Color fundus image · FOV: 45 degrees
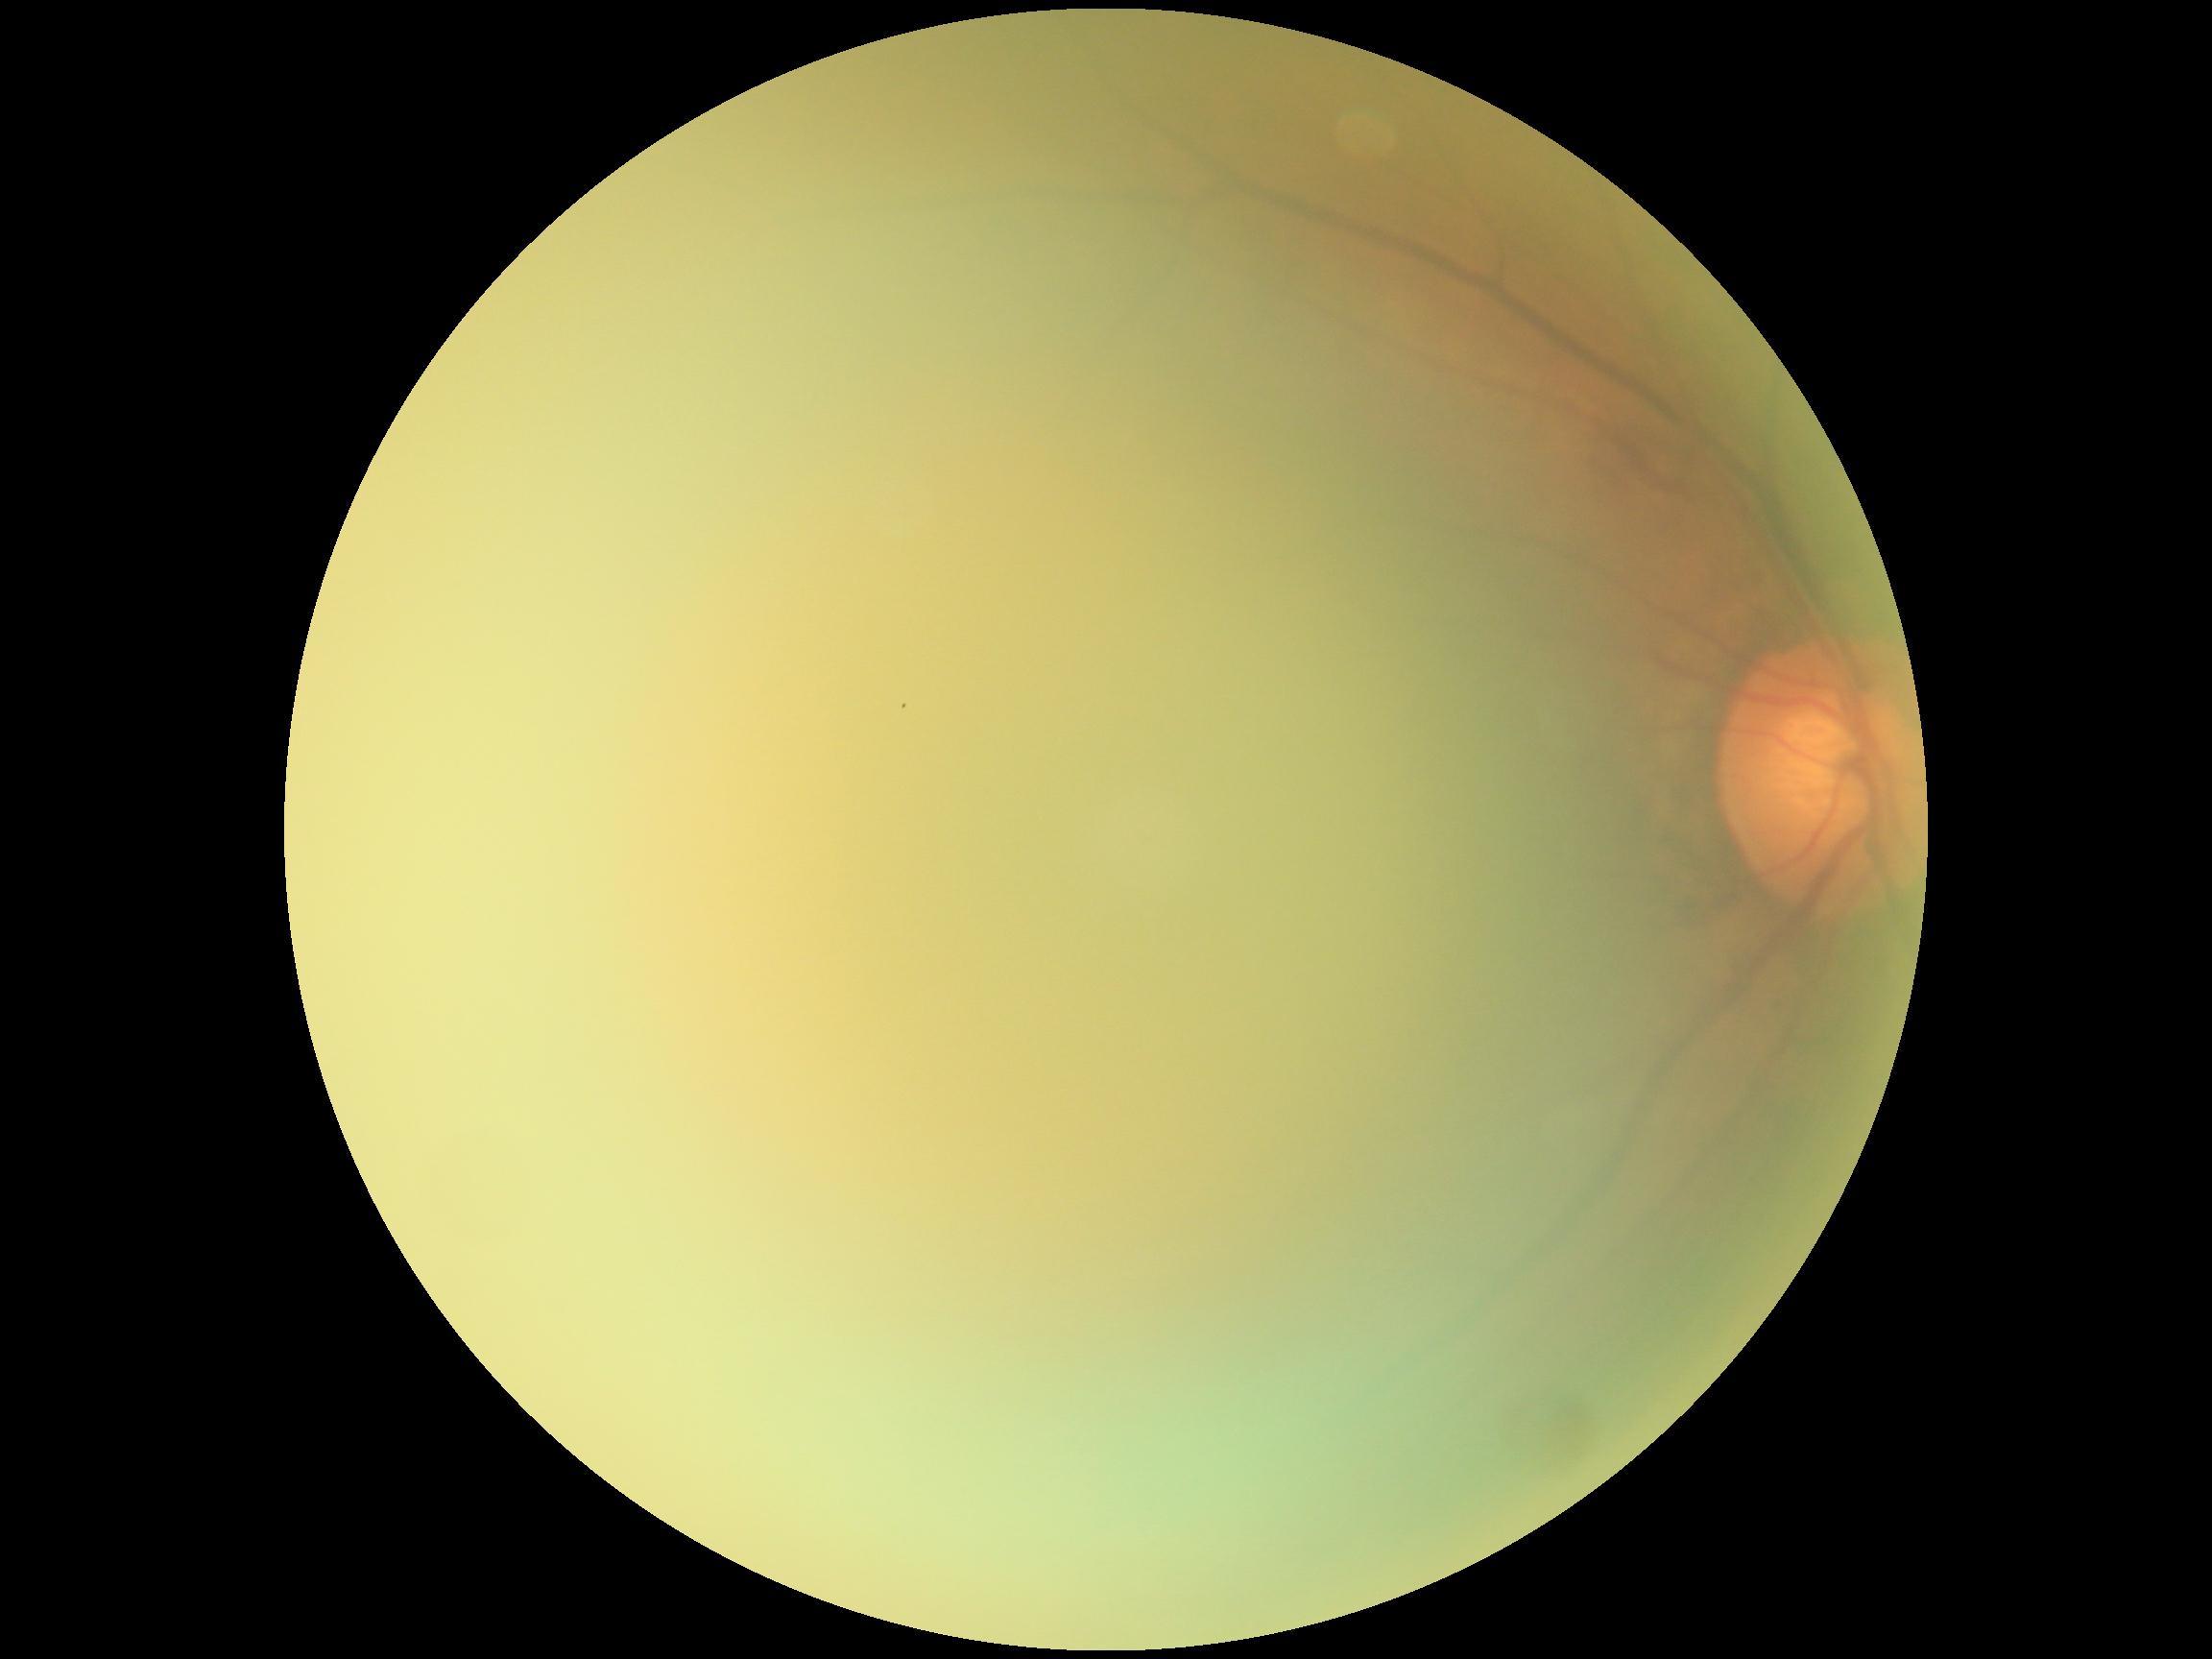   dr_grade: ungradable
  quality: below grading threshold